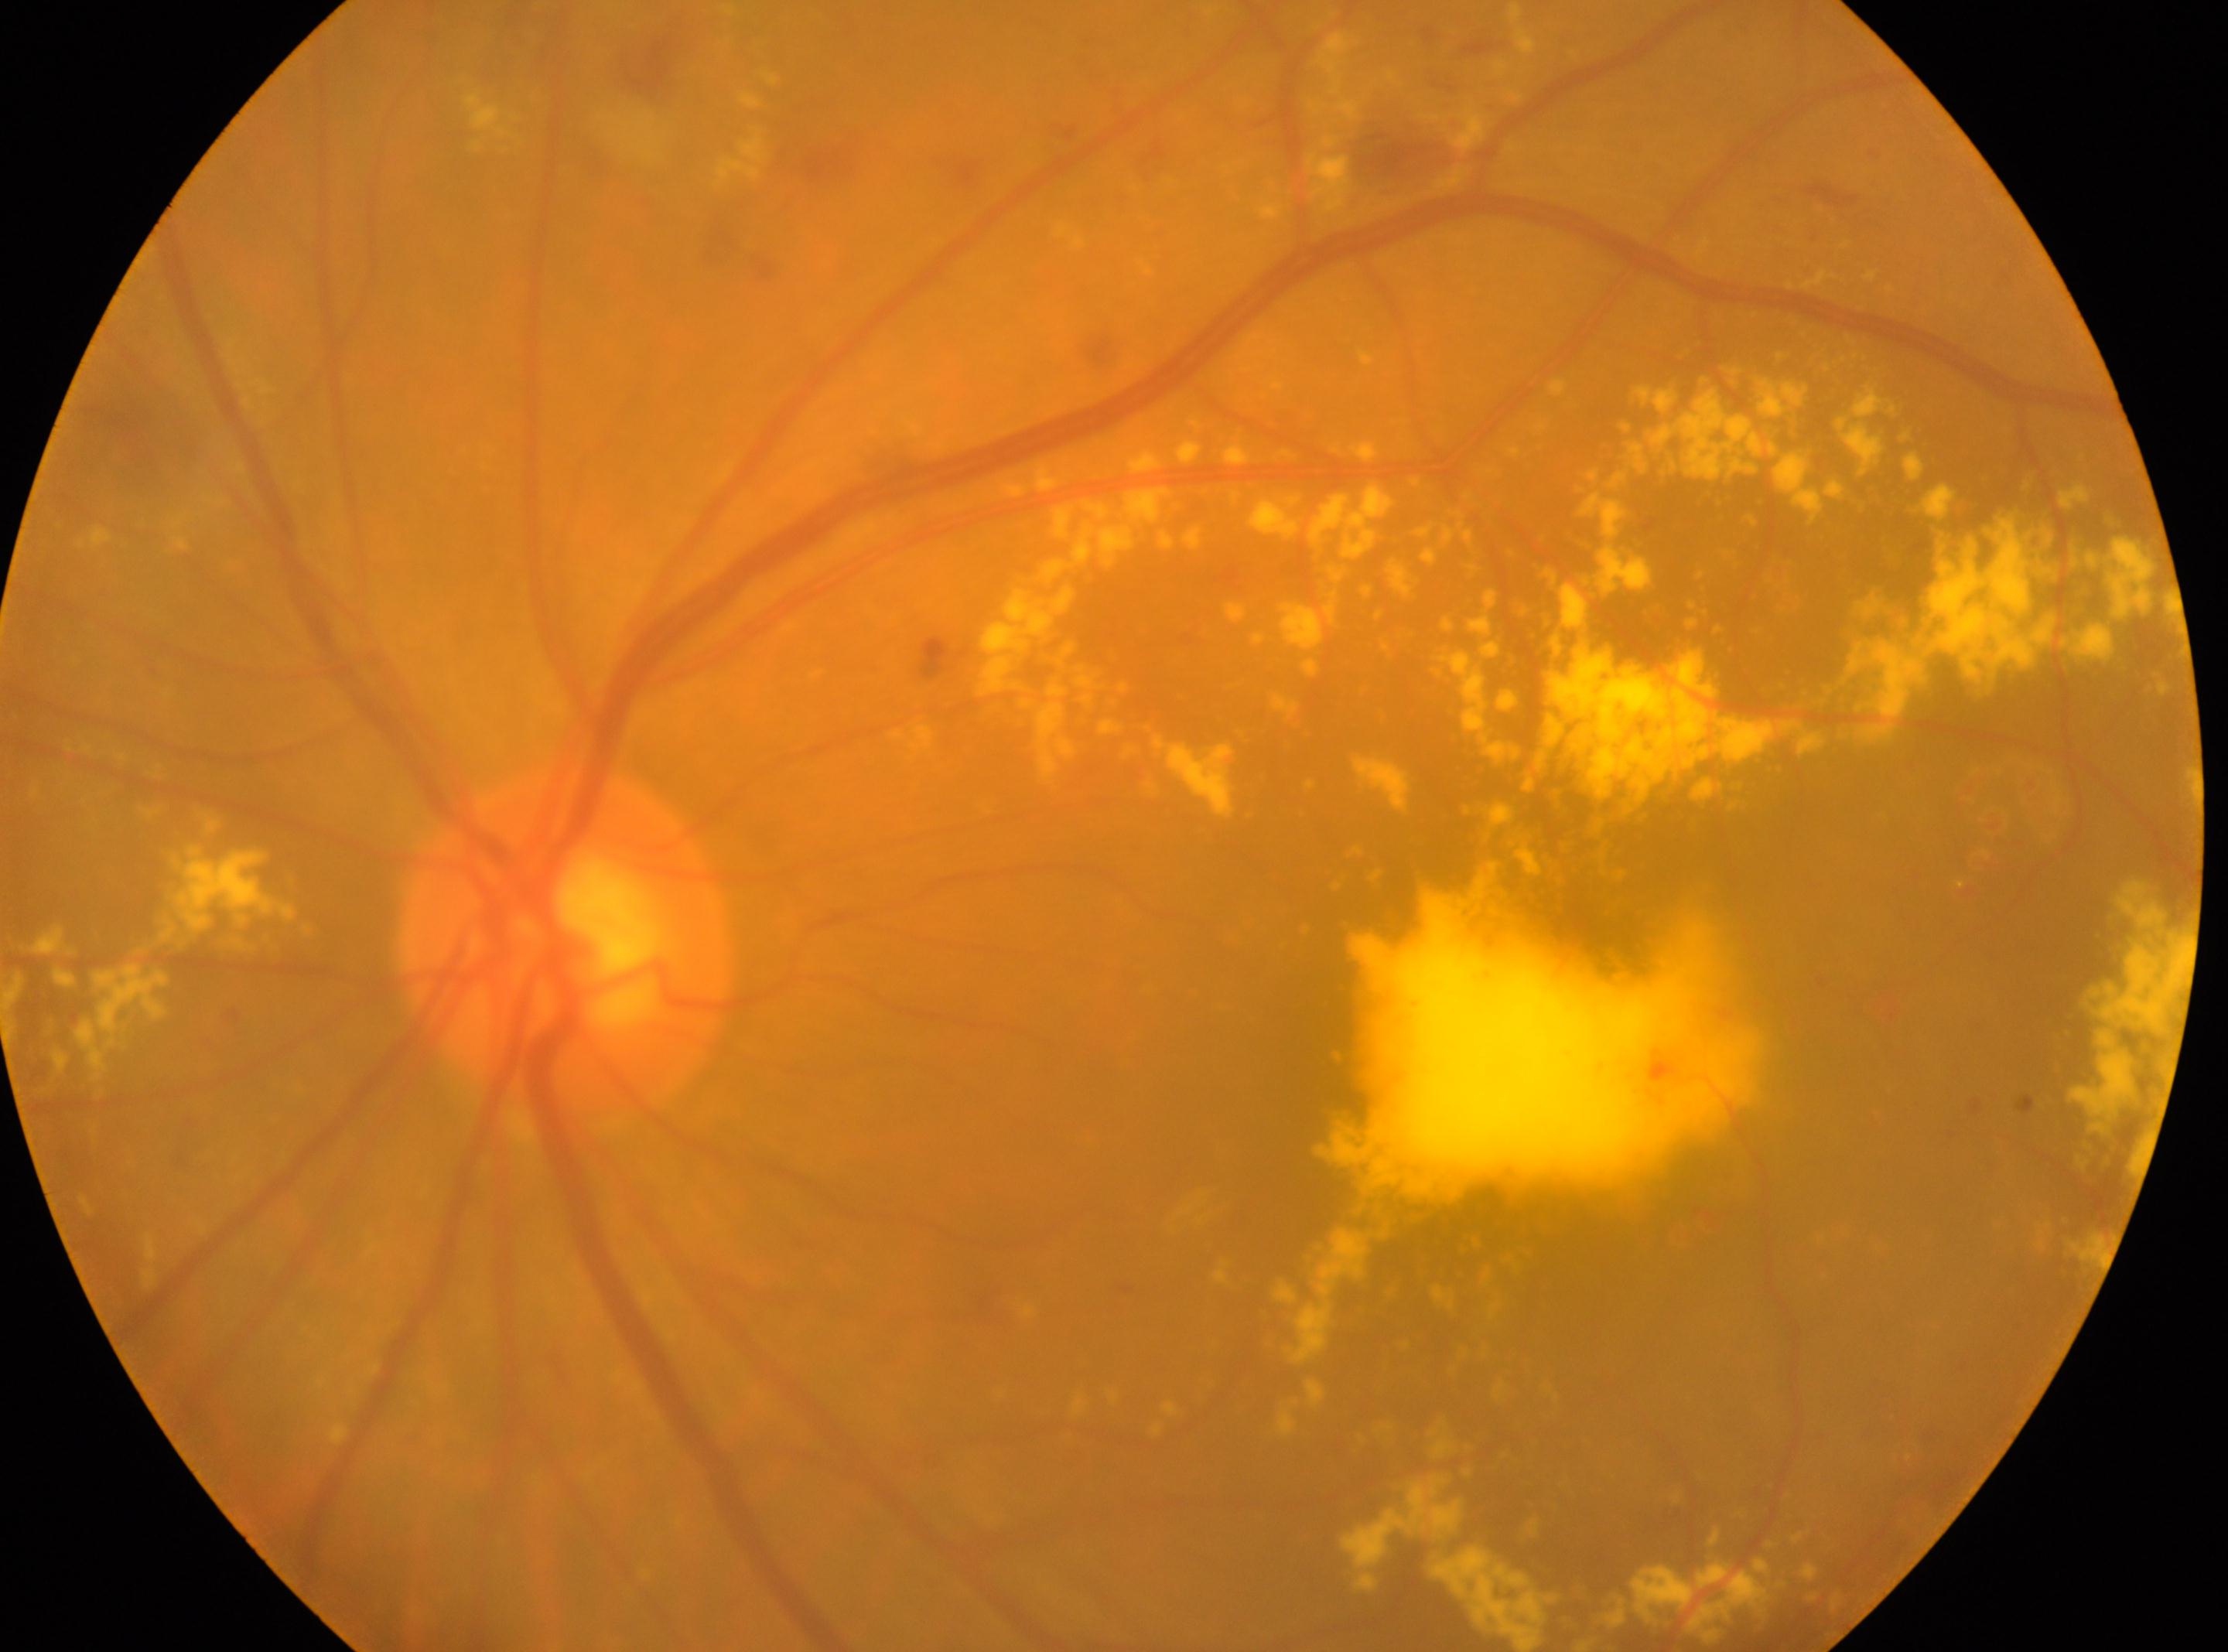
left
fovea center@1362px, 1044px
optic disc@566px, 947px
retinopathy@grade 2